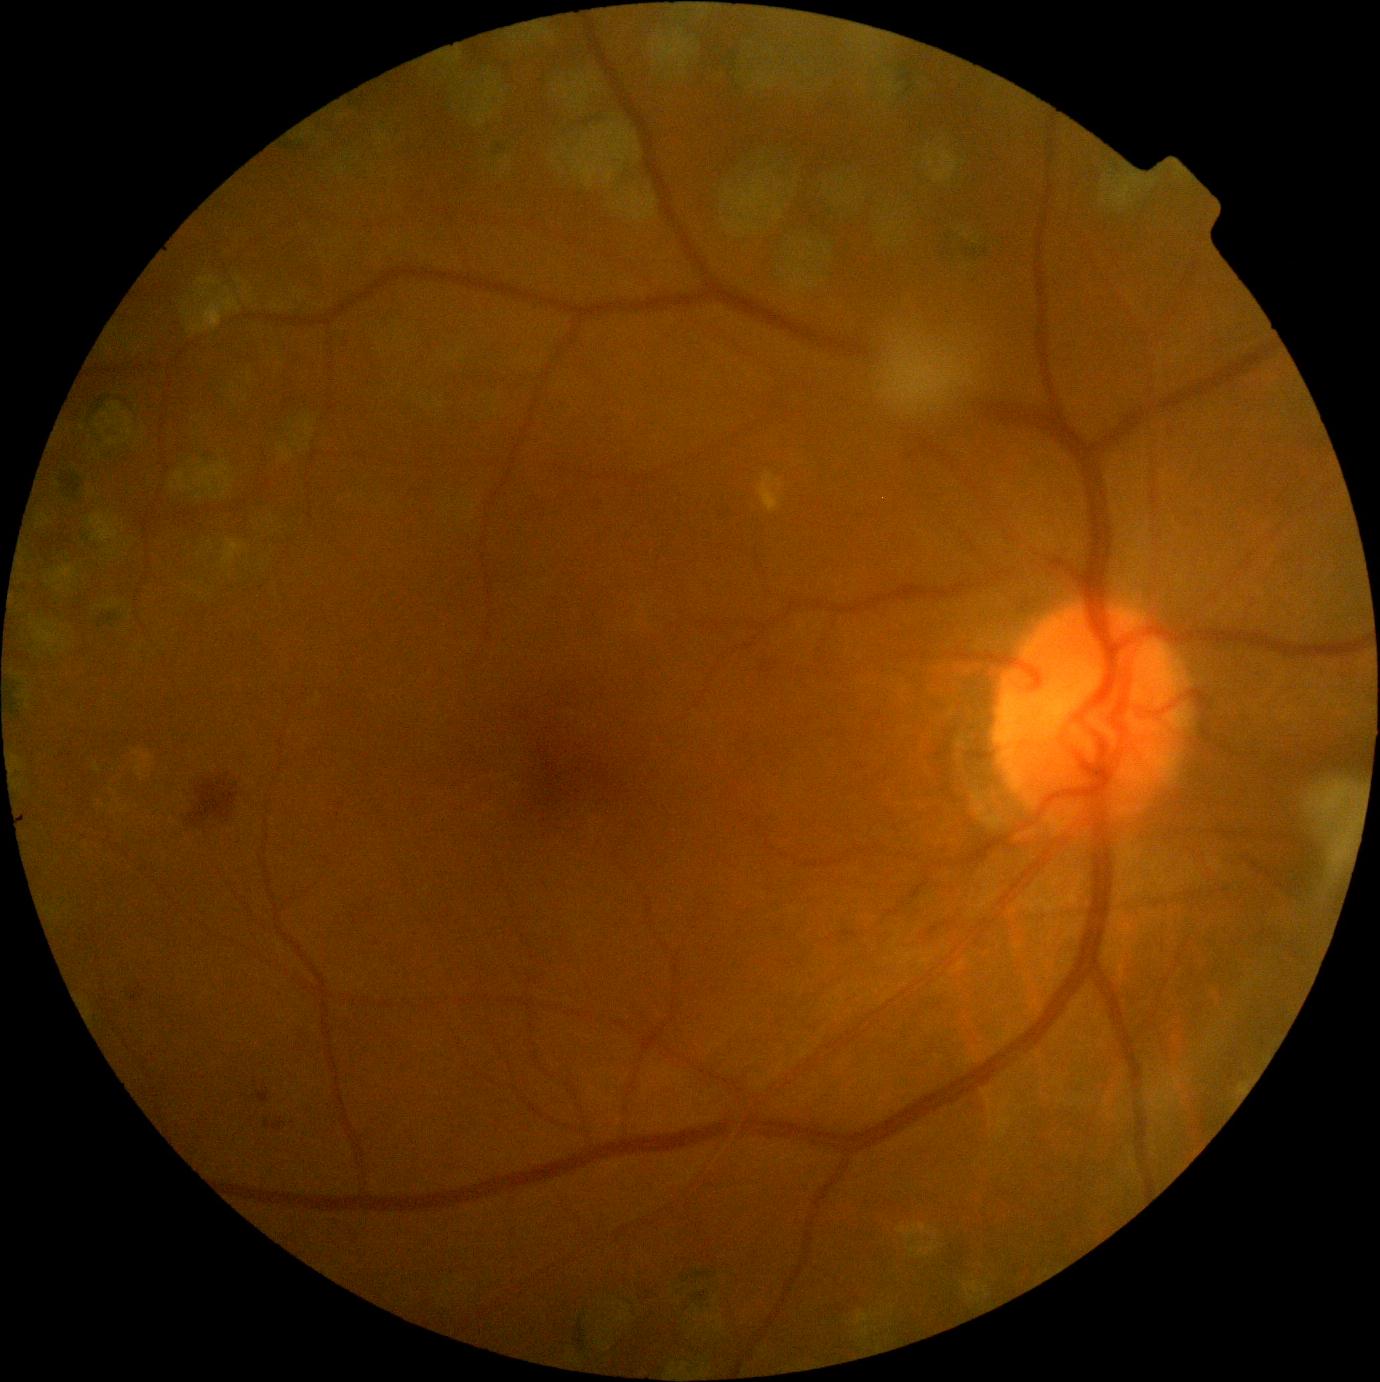

The retinopathy is classified as non-proliferative diabetic retinopathy.
DR: grade 2 (moderate NPDR).